1536x1152px; 45-degree field of view: 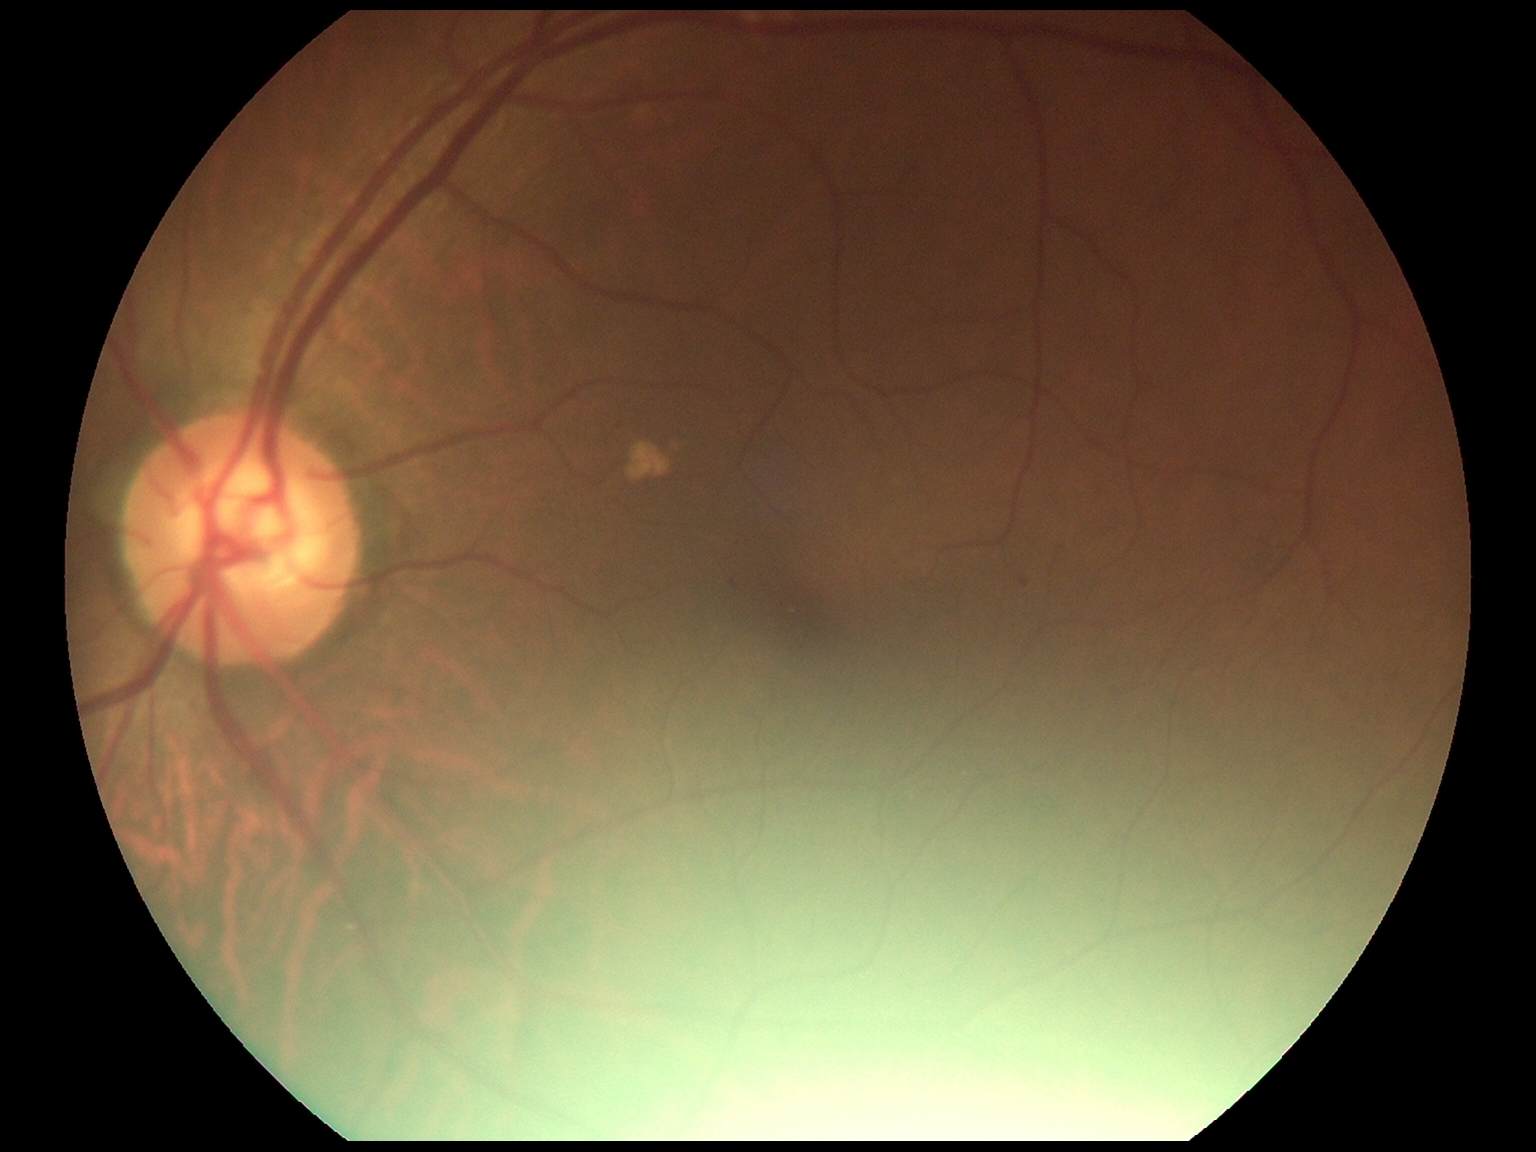 Diabetic retinopathy is grade 1 (mild NPDR).